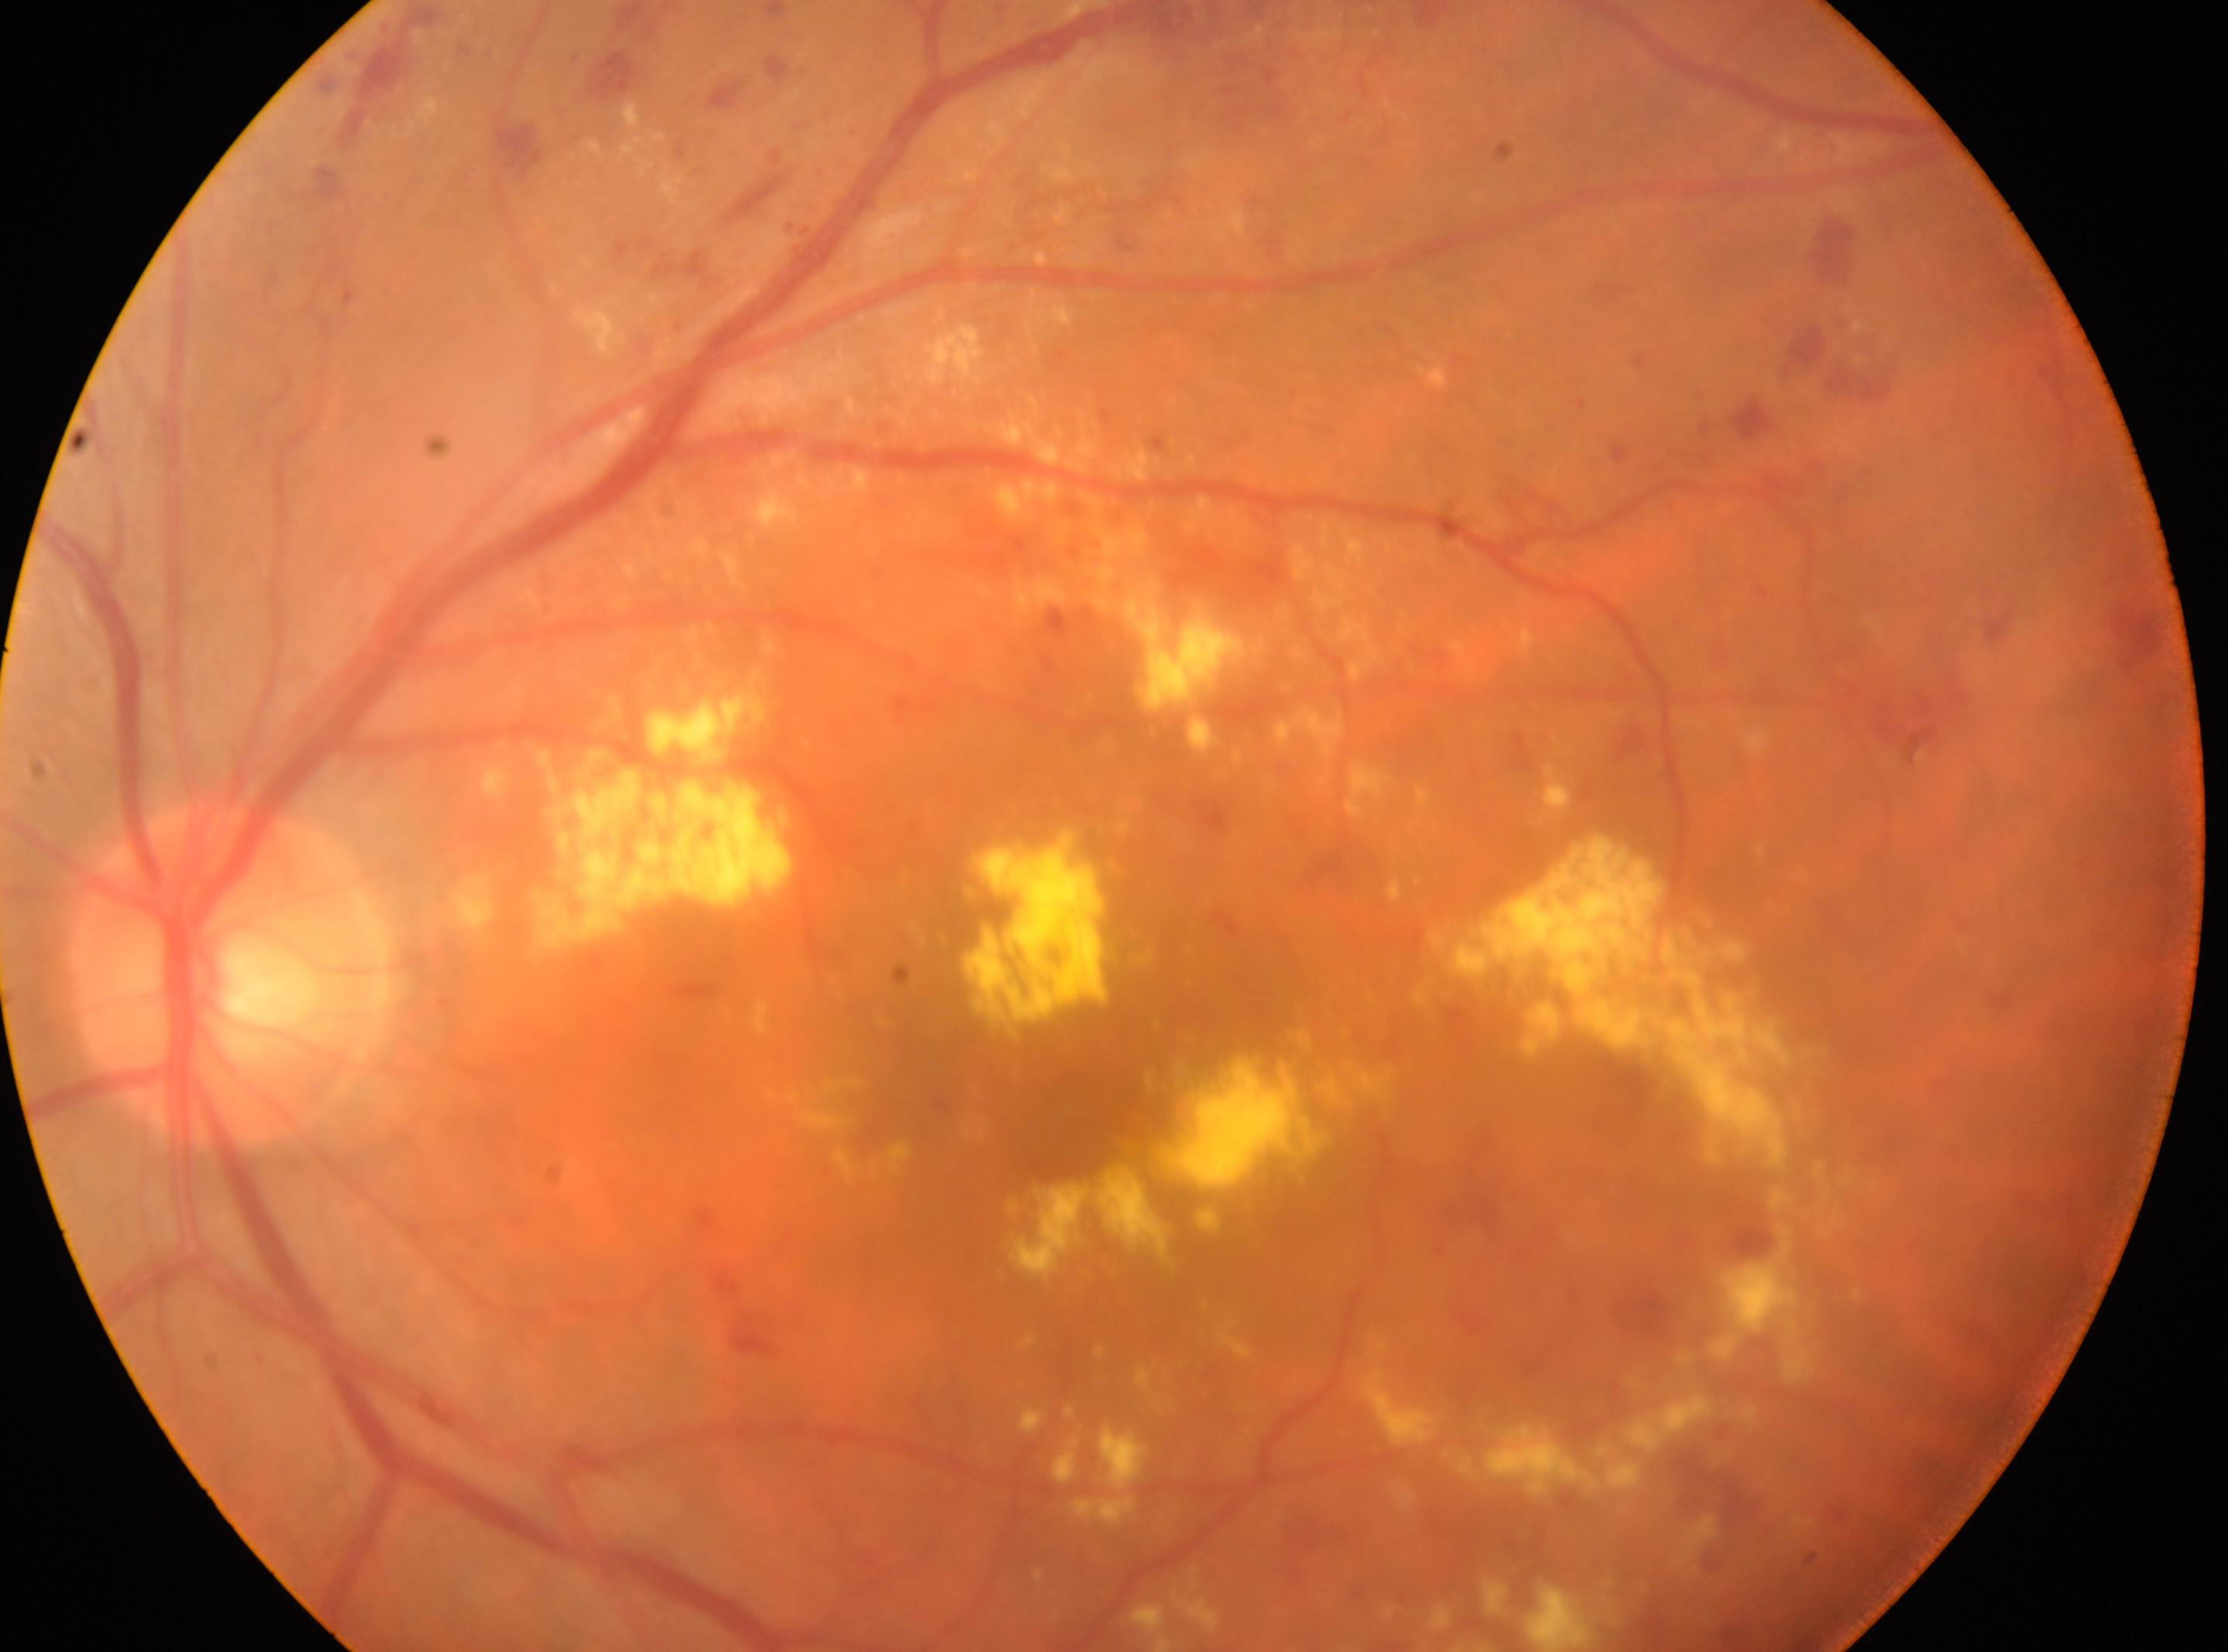 DR severity is grade 2 (moderate NPDR) — more than just microaneurysms but less than severe NPDR.
Fovea centralis located at (x=1068, y=1131).
The image shows the oculus sinister.
DR class: non-proliferative diabetic retinopathy.
Optic disc located at (x=224, y=971).